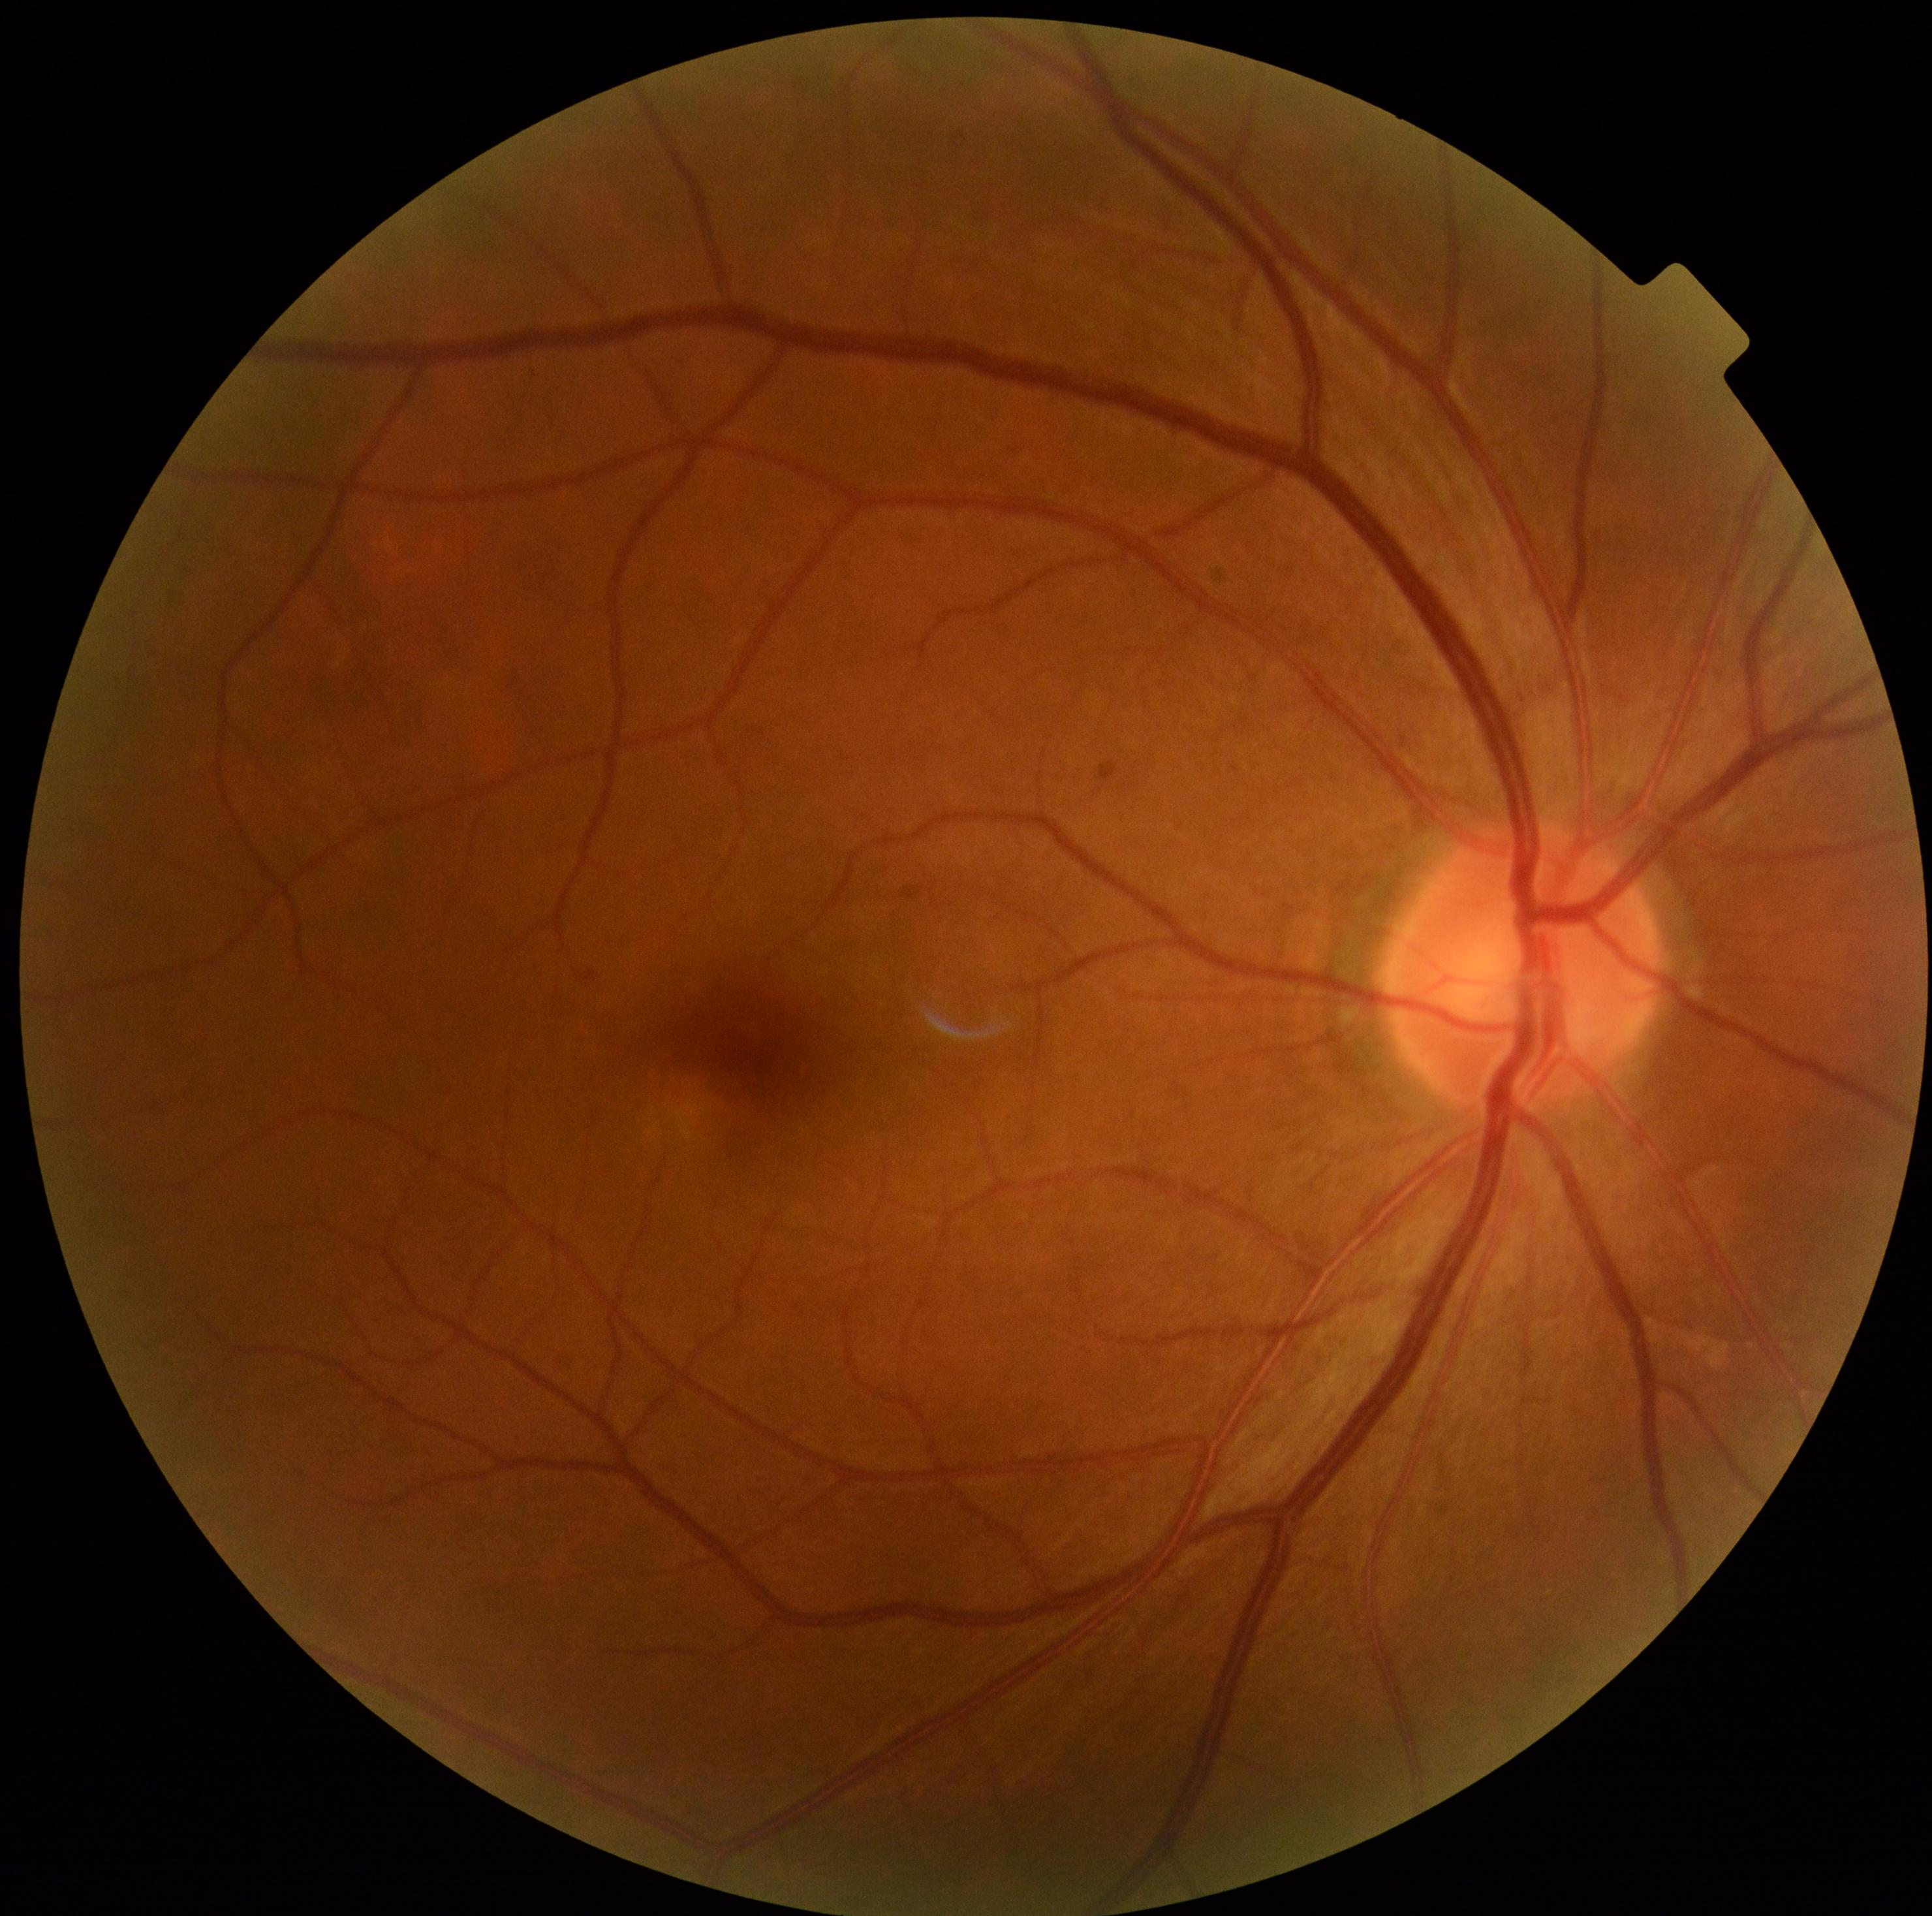
Diabetic retinopathy (DR): grade 0 — no visible signs of diabetic retinopathy.